Color fundus image; captured after pupil dilation: 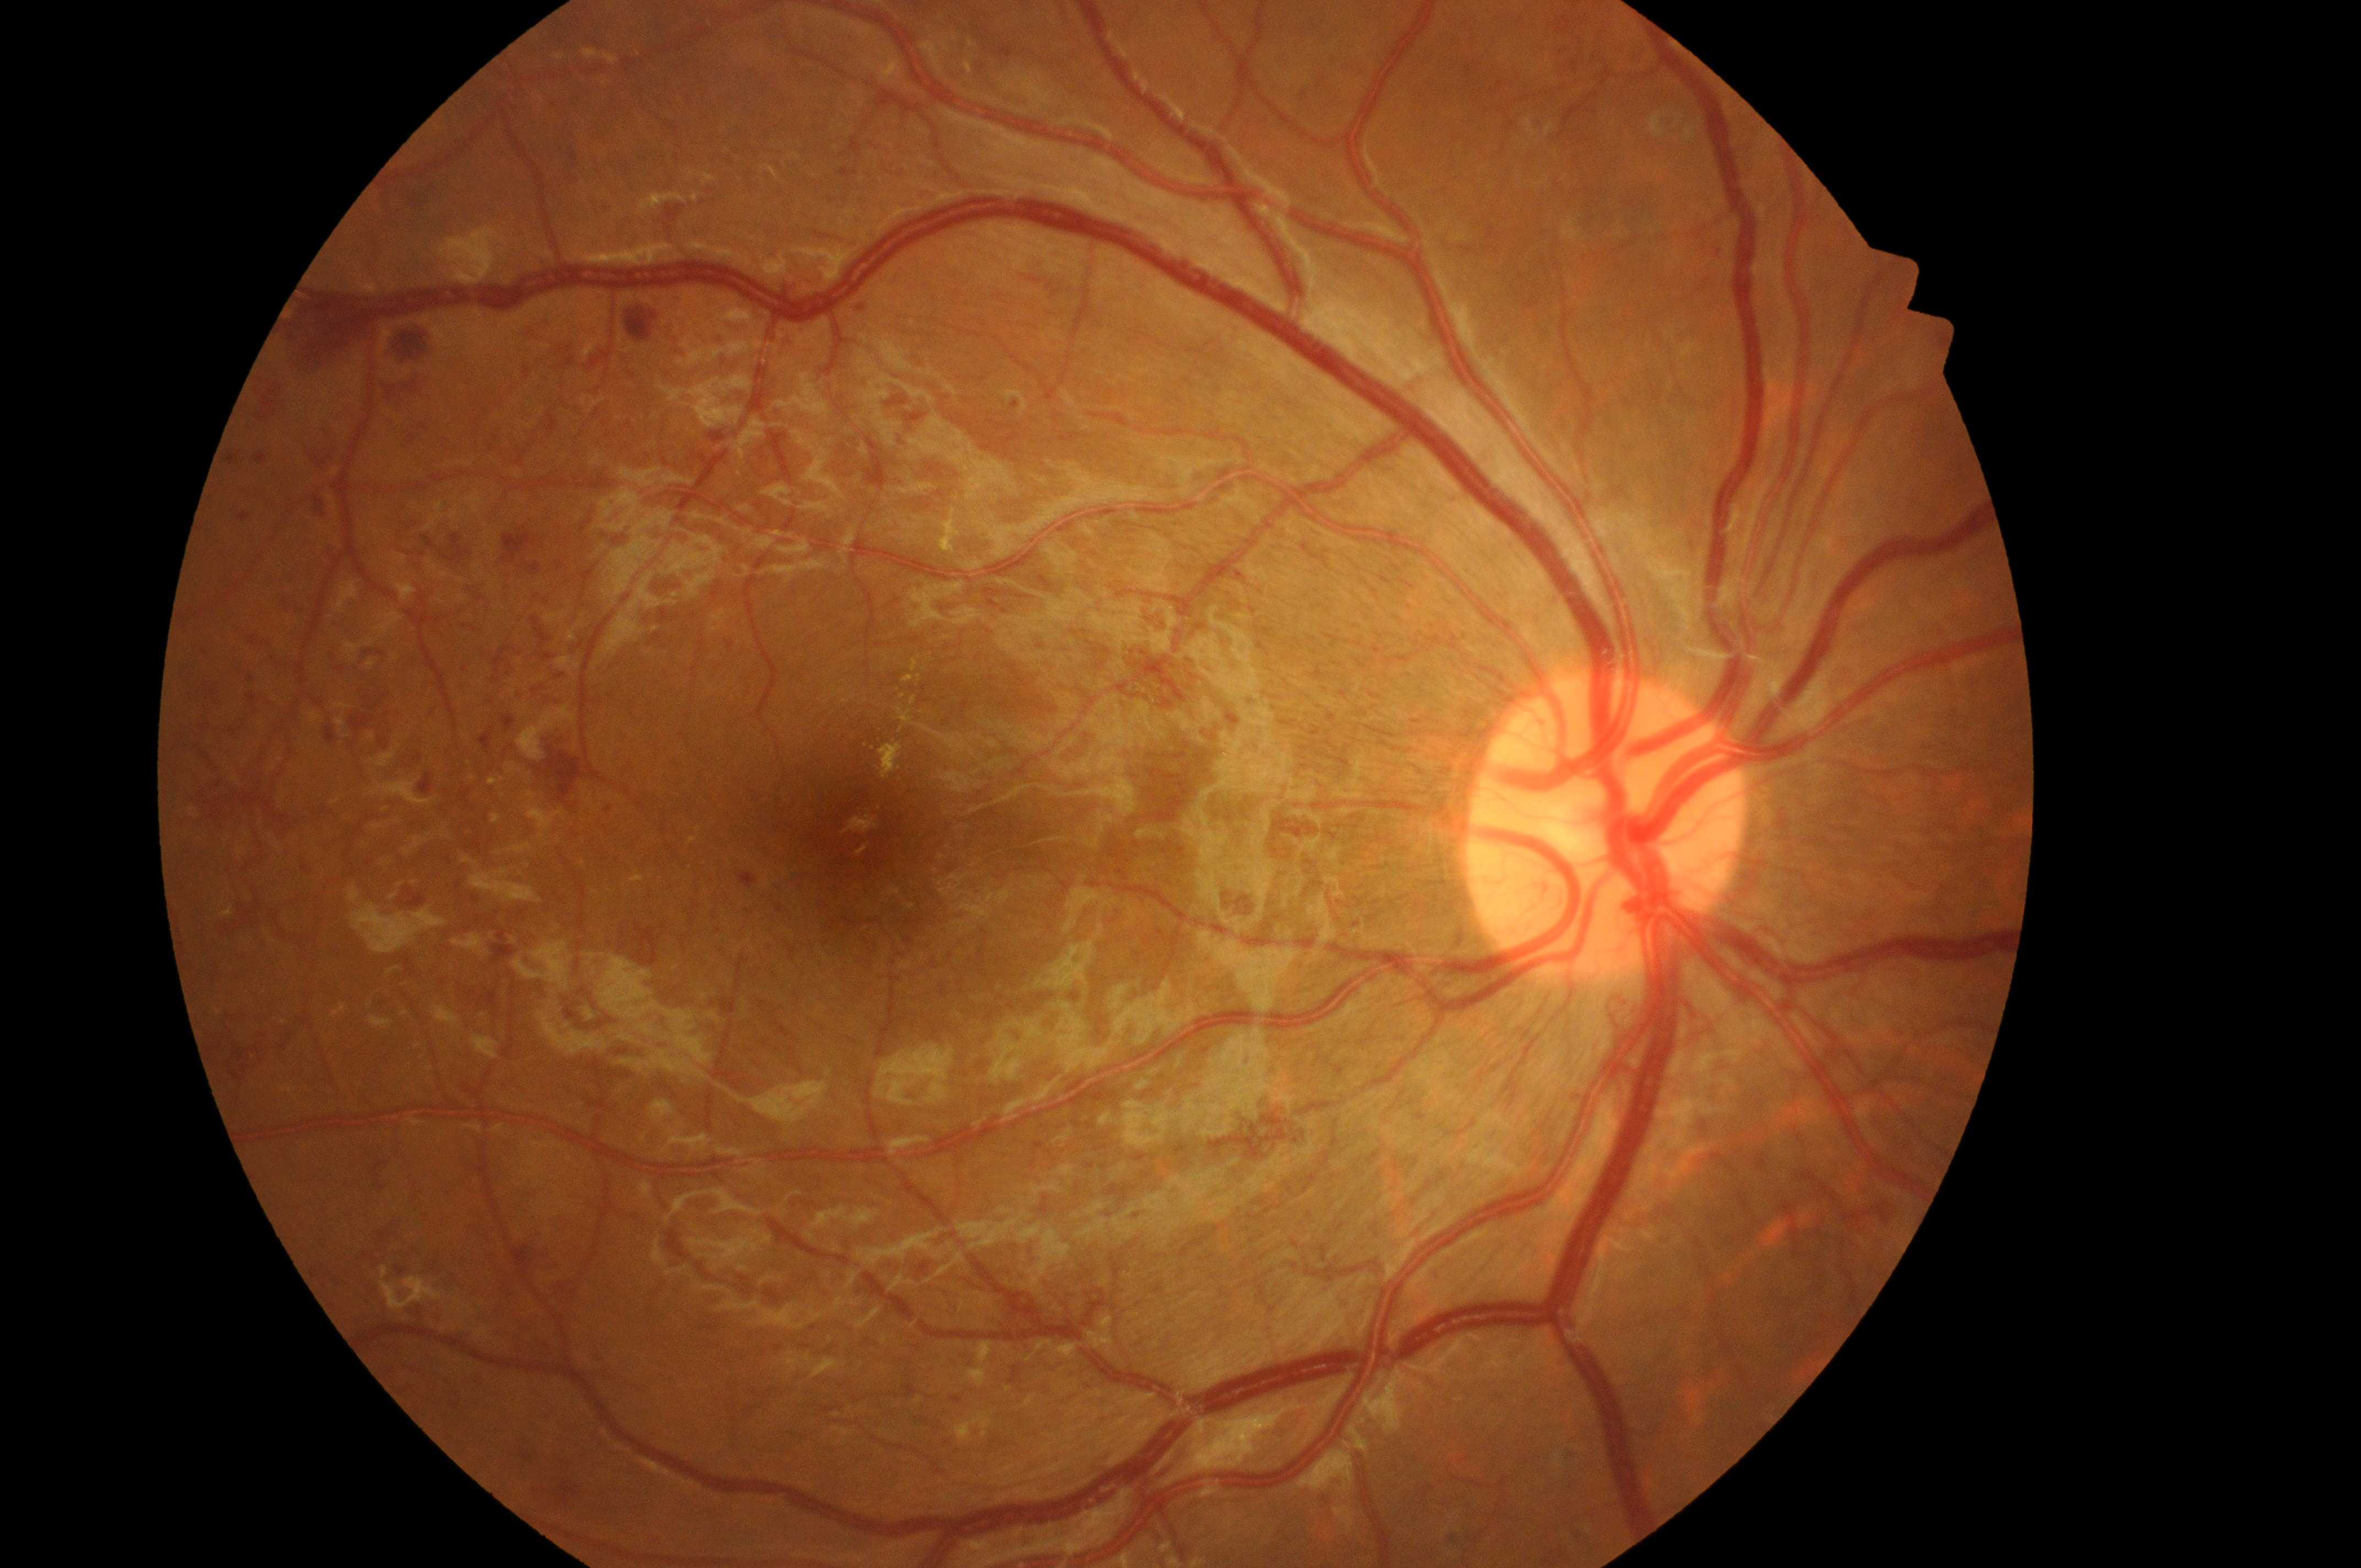

Imaged eye: OD. Diabetic macular edema (DME): high risk (grade 2). Optic nerve head located at [1603, 841]. Diabetic retinopathy (DR) is grade 4 (PDR). The fovea is at [860, 843].